Davis DR grading
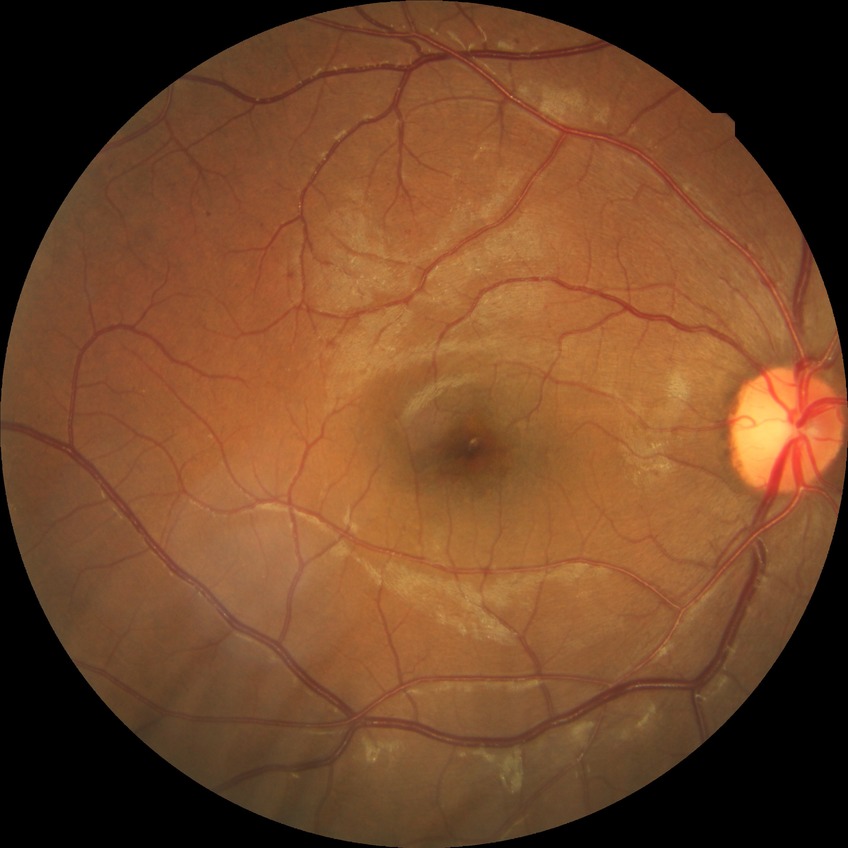
Diabetic retinopathy stage: simple diabetic retinopathy.